Image size 2352x1568:
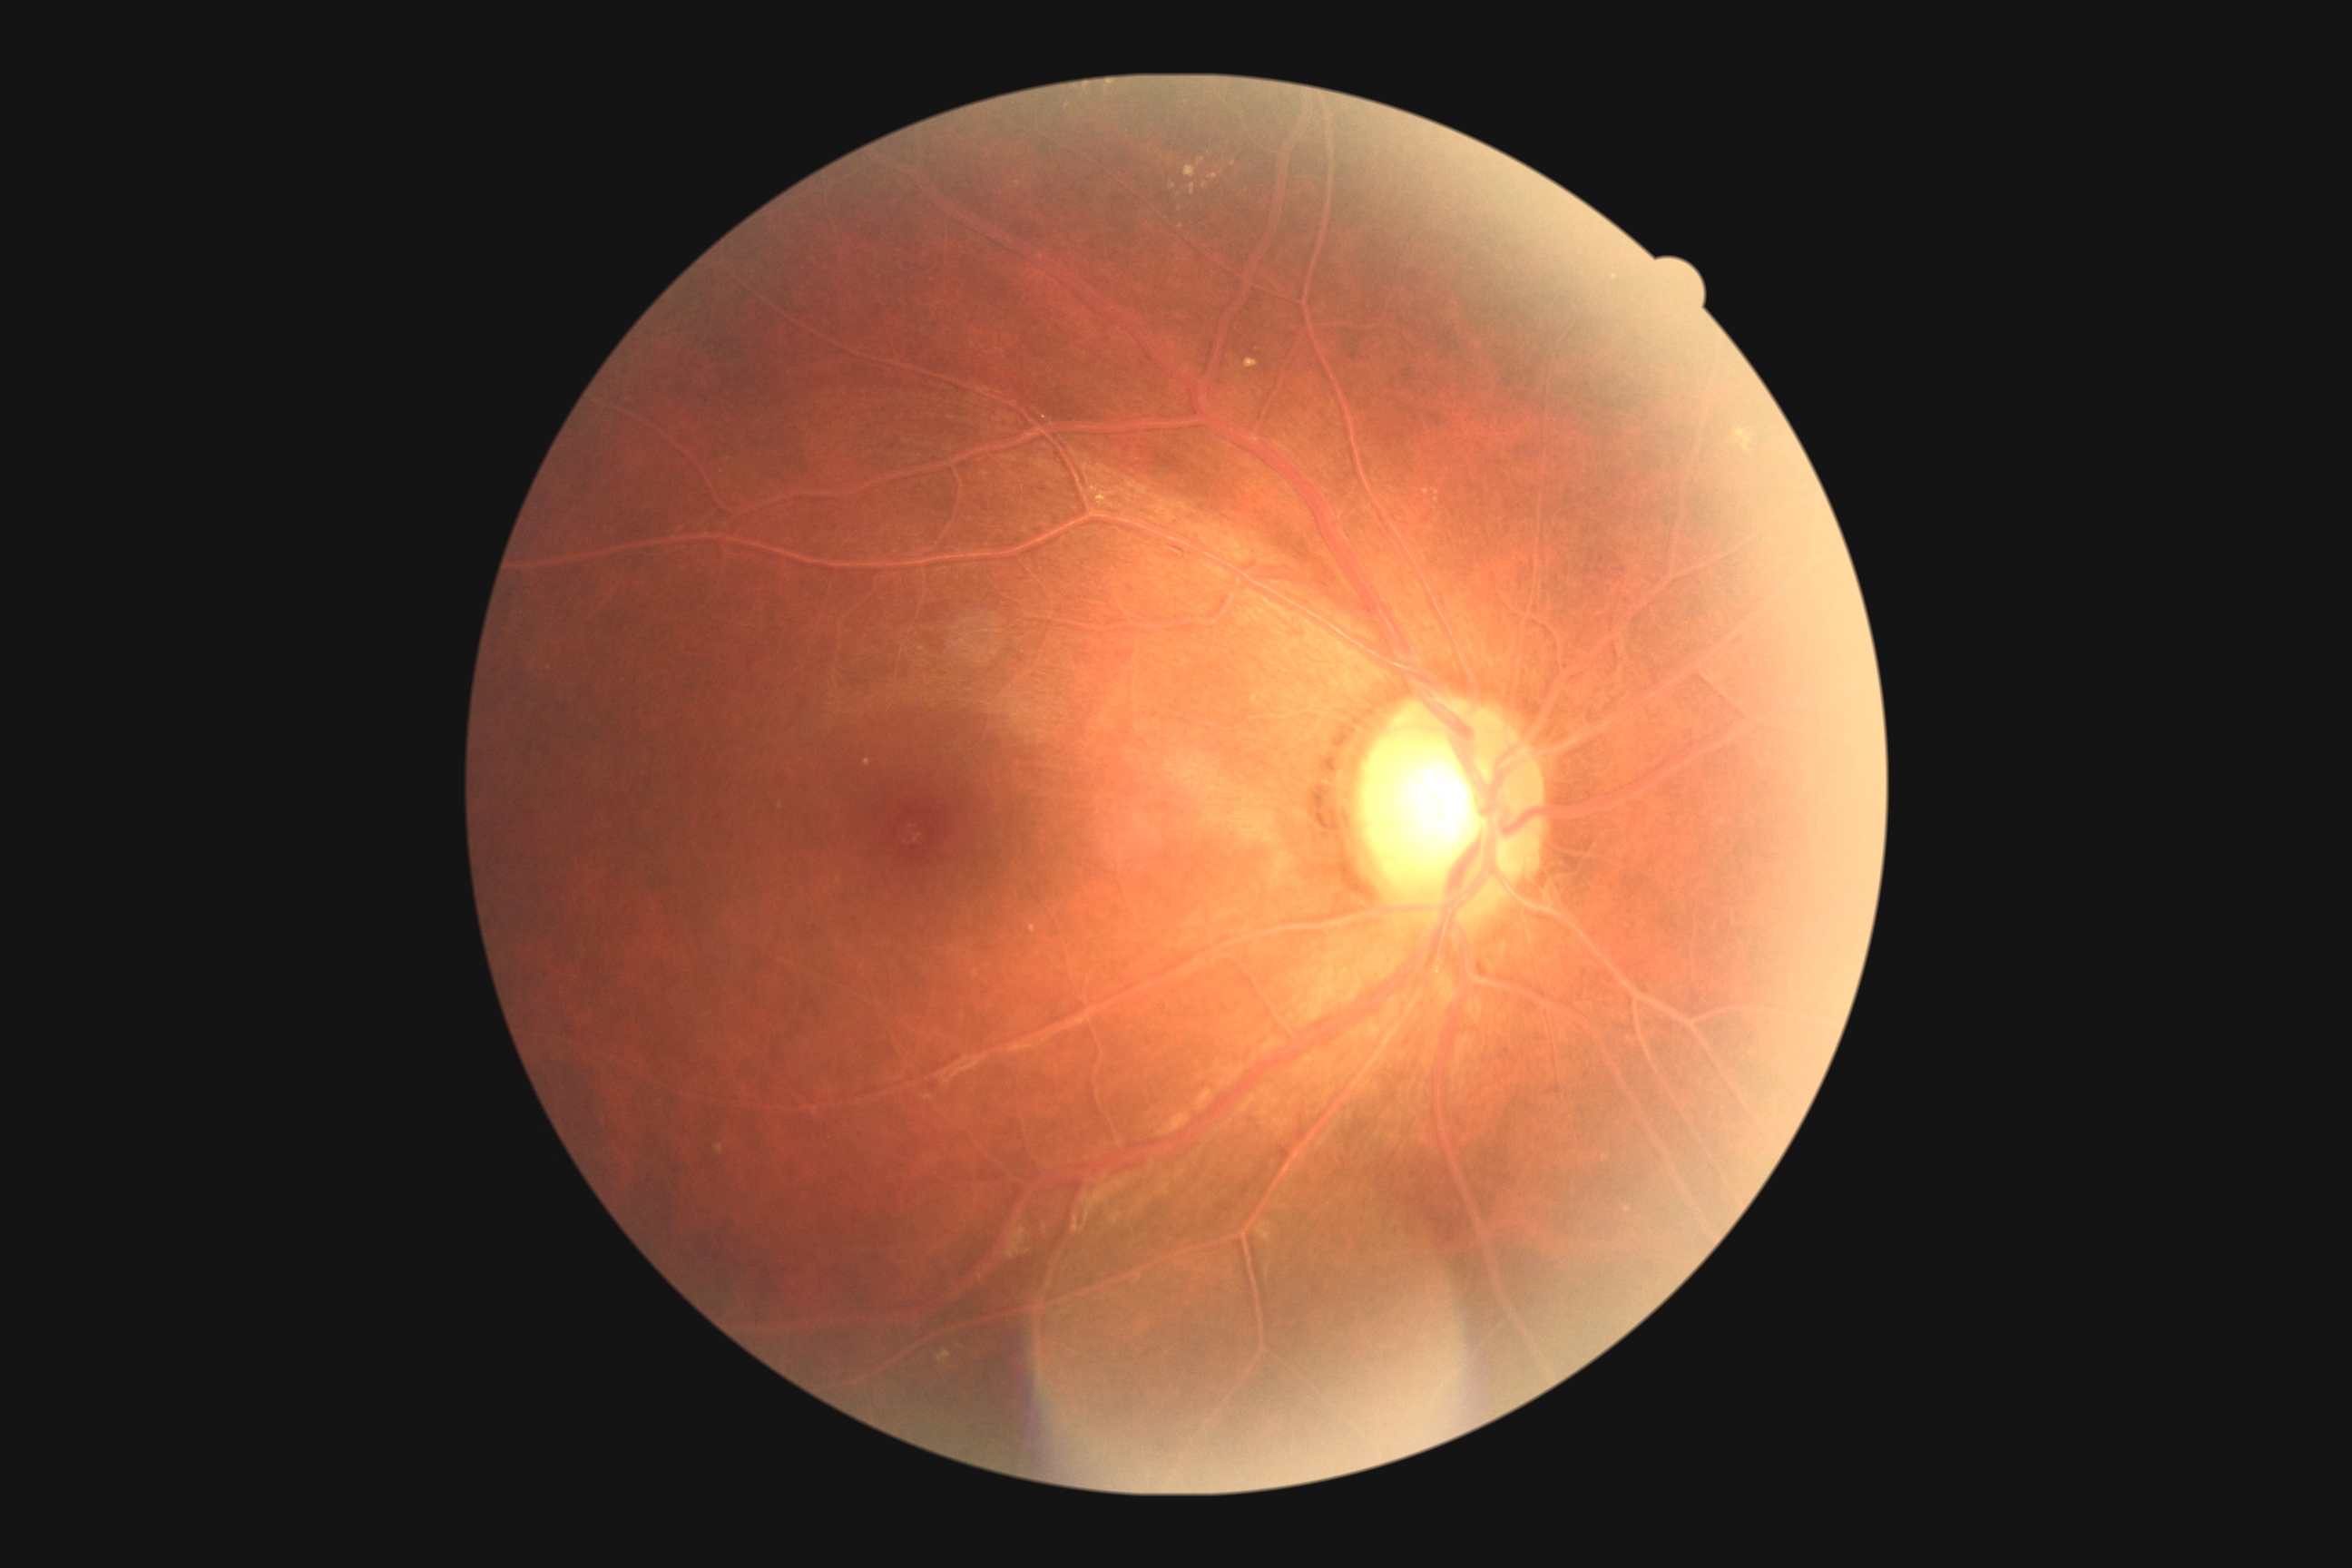
  dr_grade: 2 (moderate NPDR)